Color fundus photograph
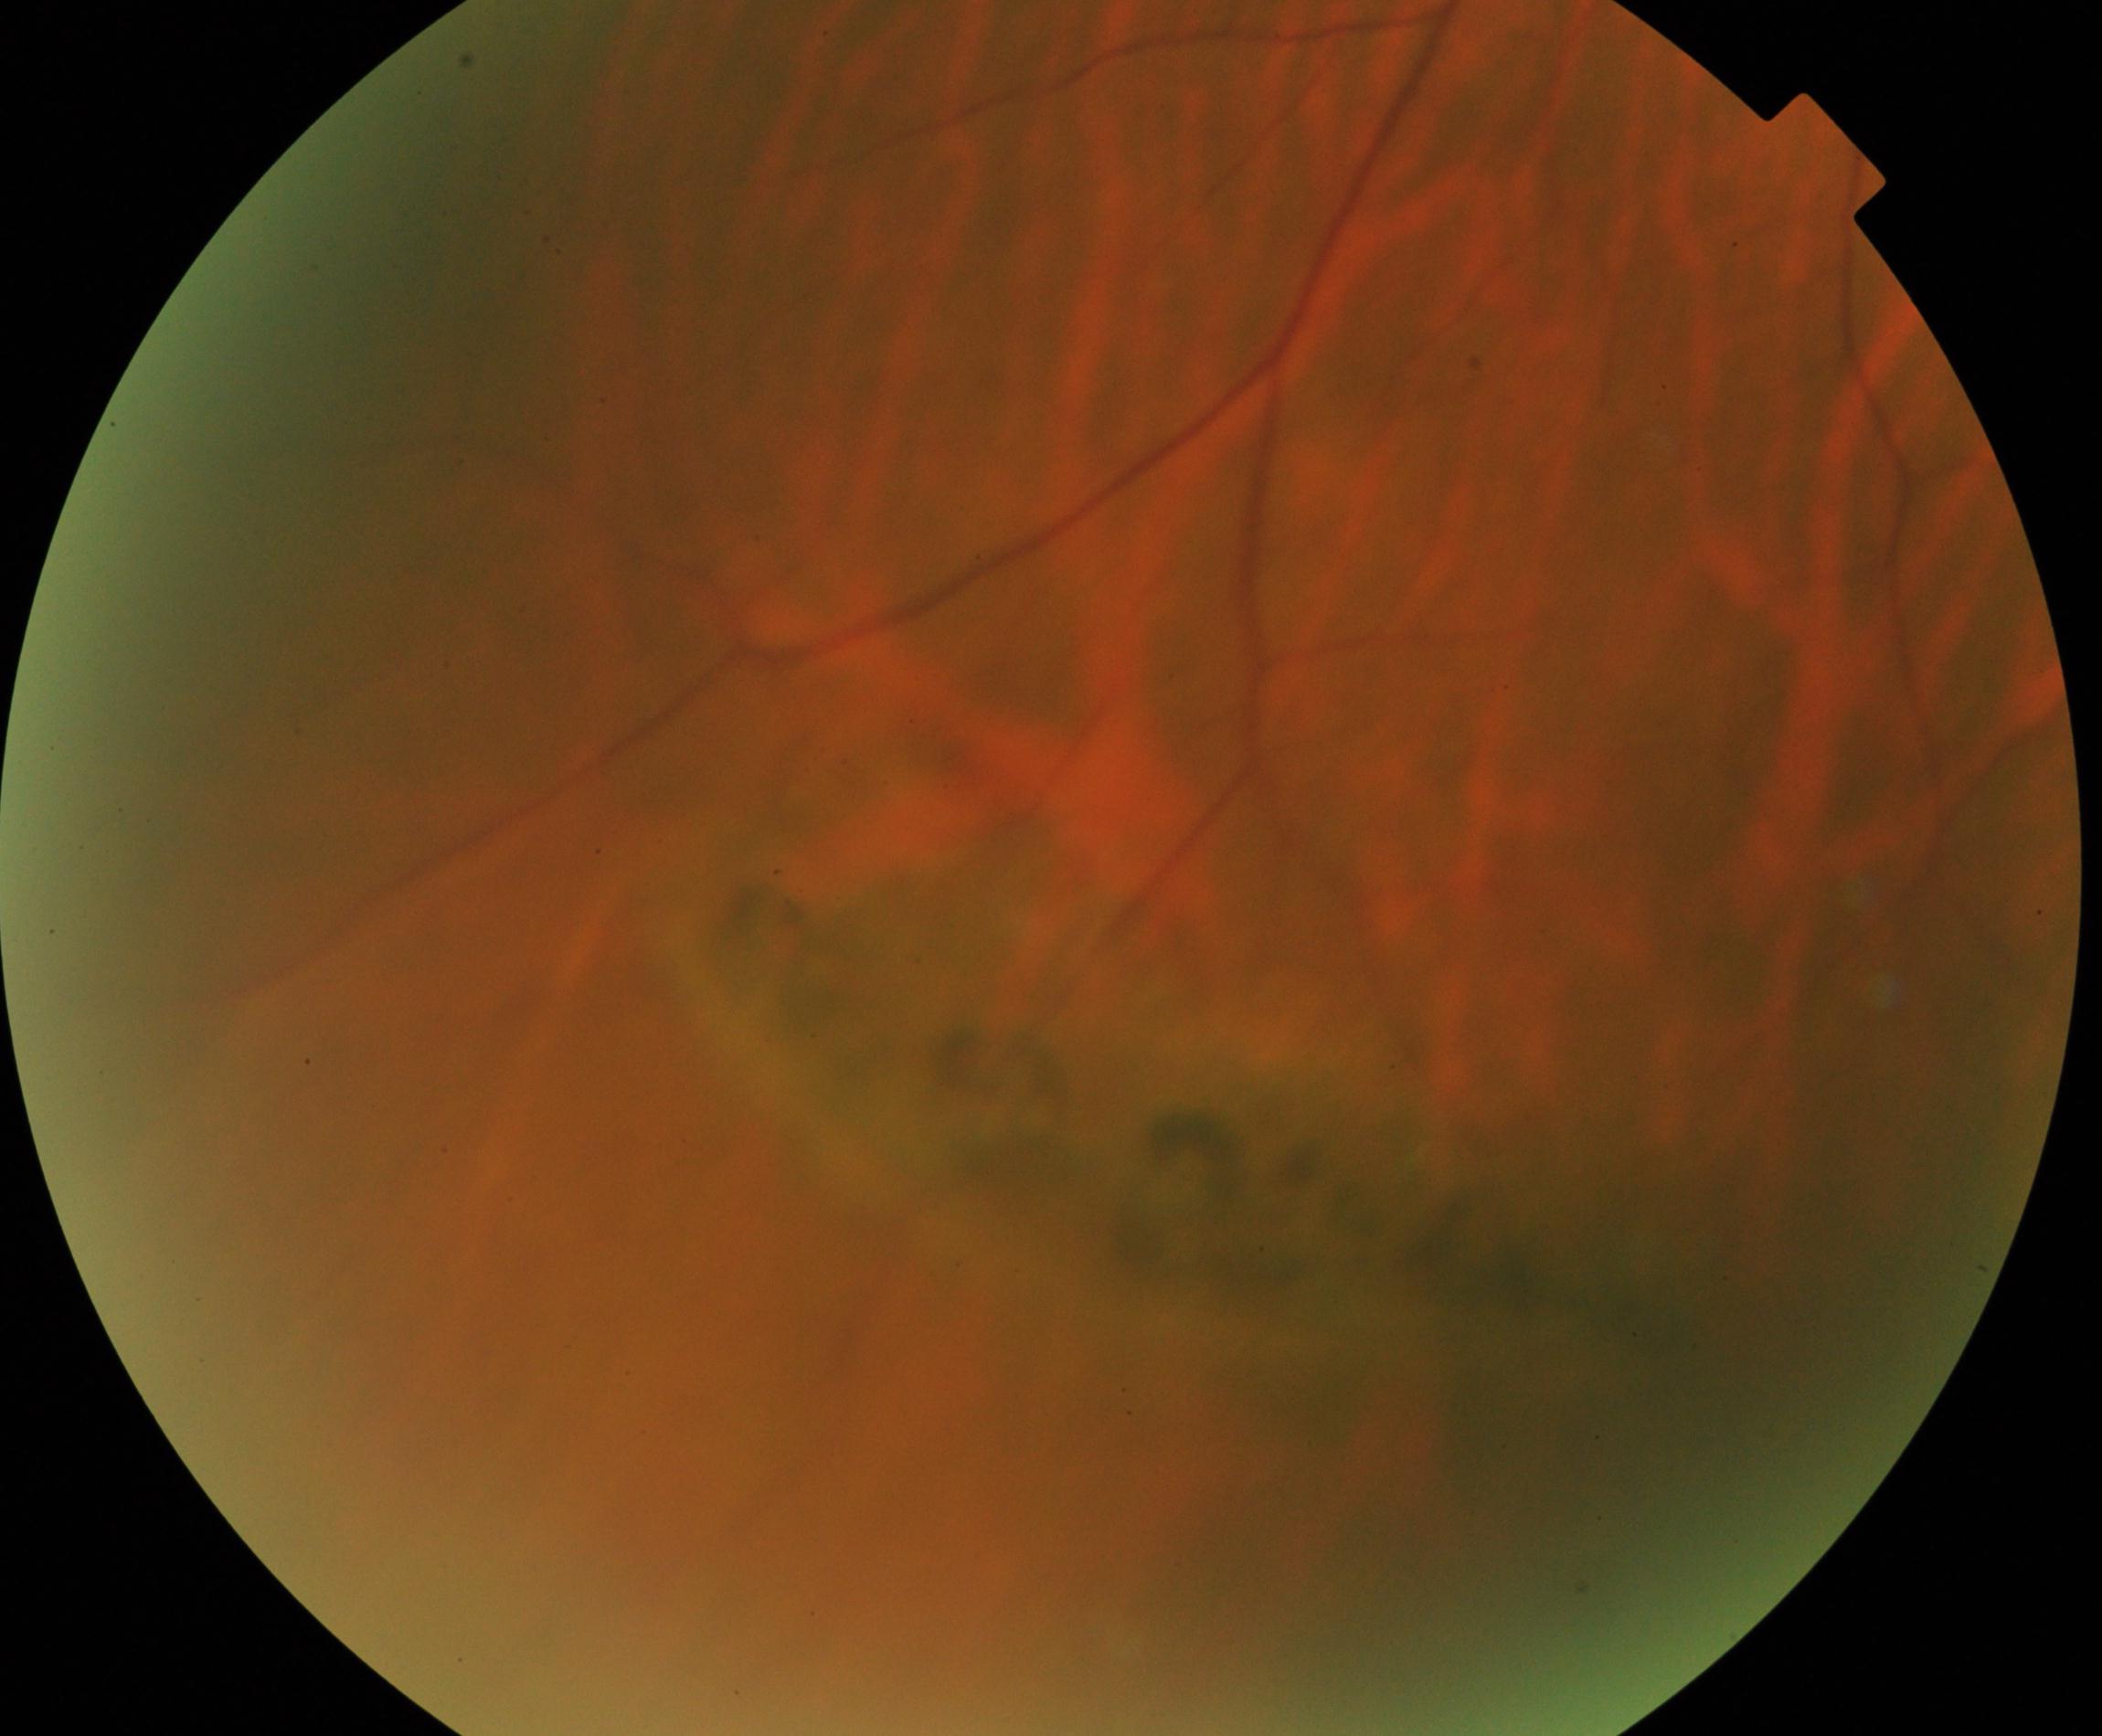 Demonstrates peripheral retinal degeneration and break.